Acquired on the Clarity RetCam 3 · wide-field fundus photograph from neonatal ROP screening:
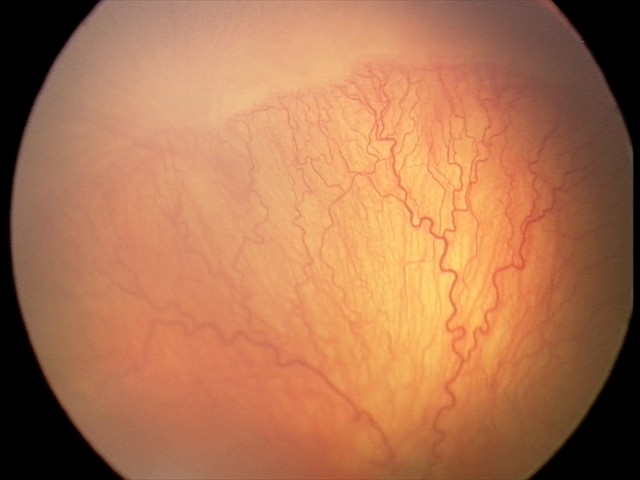

Screening examination consistent with aggressive retinopathy of prematurity — rapidly progressive severe ROP with prominent plus disease, often without classic stage progression.